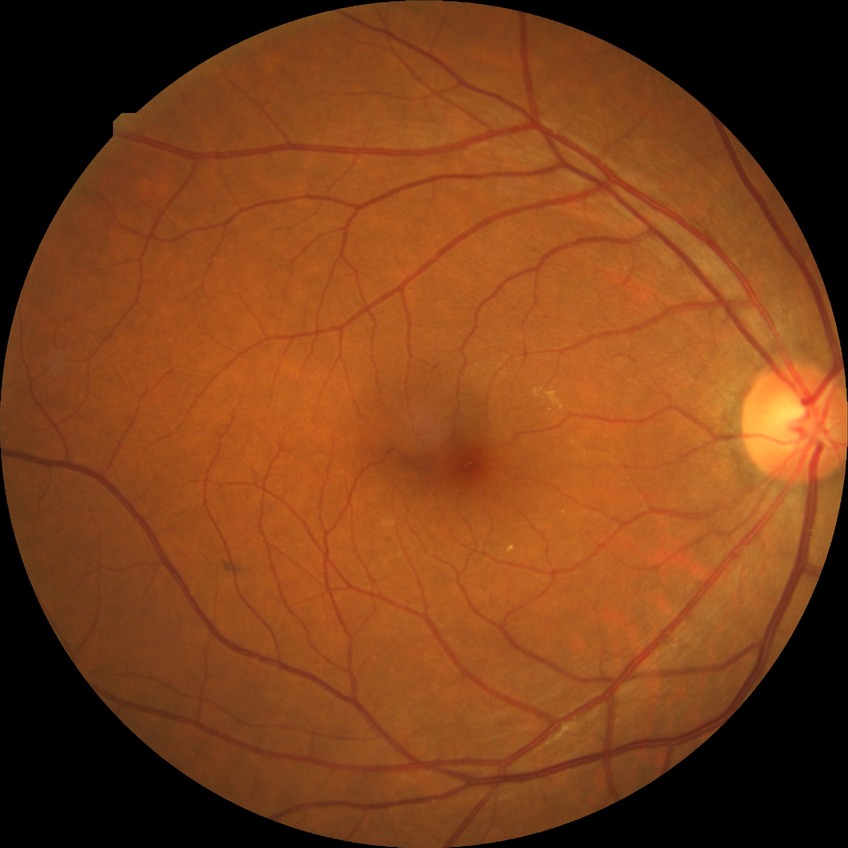
diabetic retinopathy (DR) = simple diabetic retinopathy (SDR).